Natus RetCam Envision, 130° FOV · infant wide-field fundus photograph:
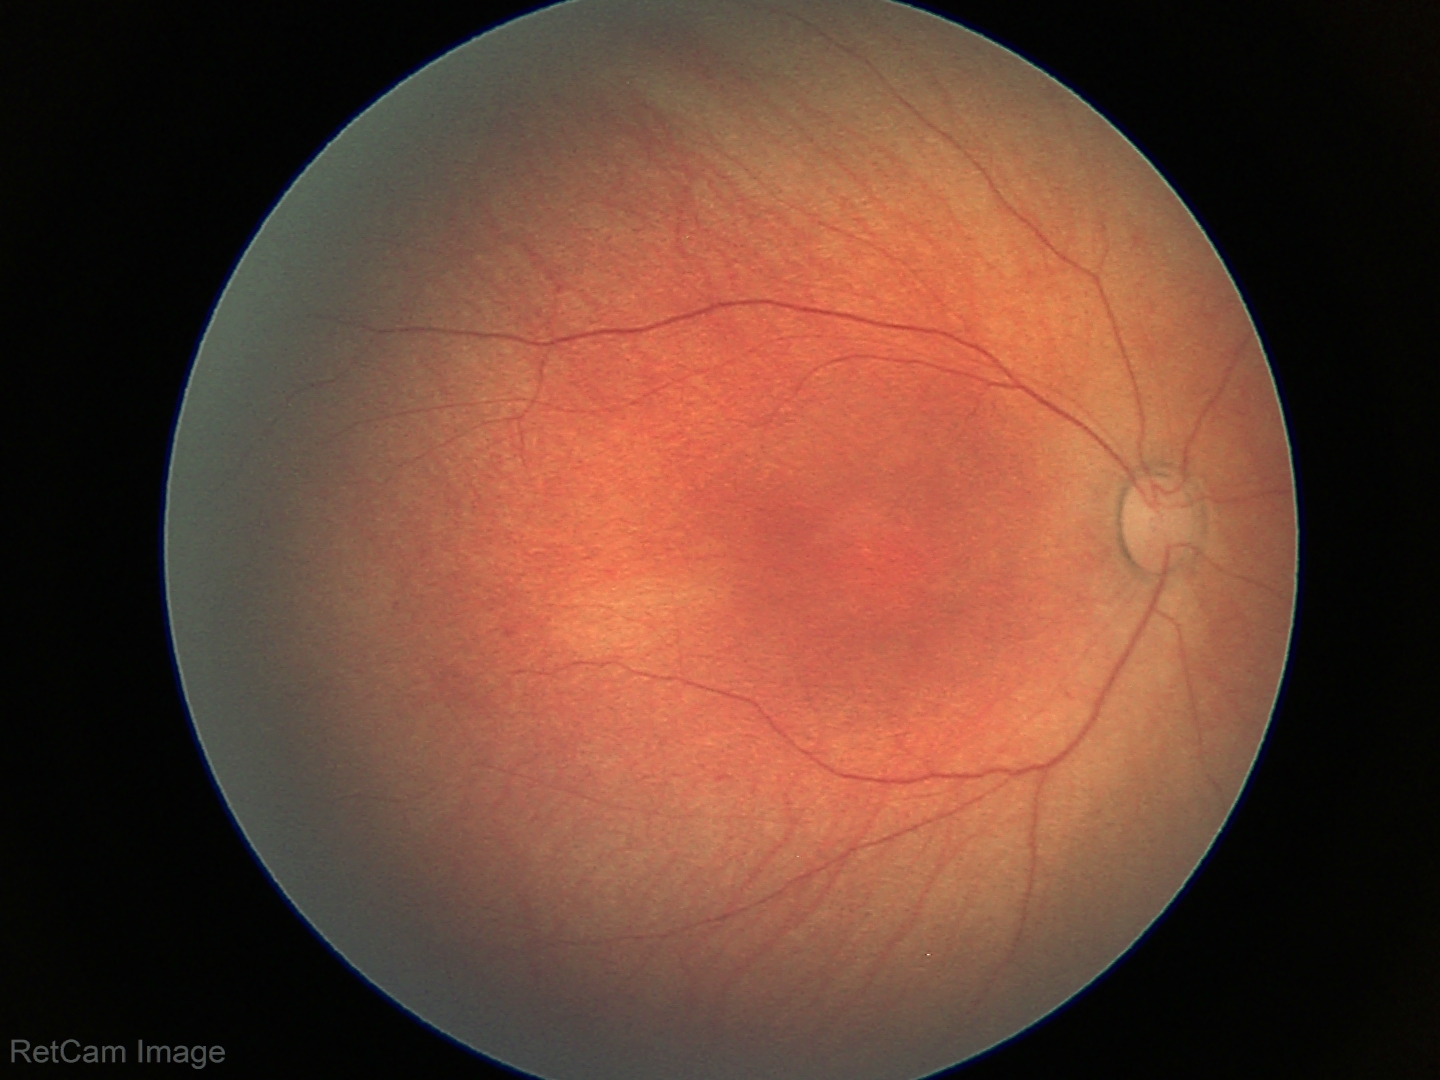 Examination with physiological retinal findings.